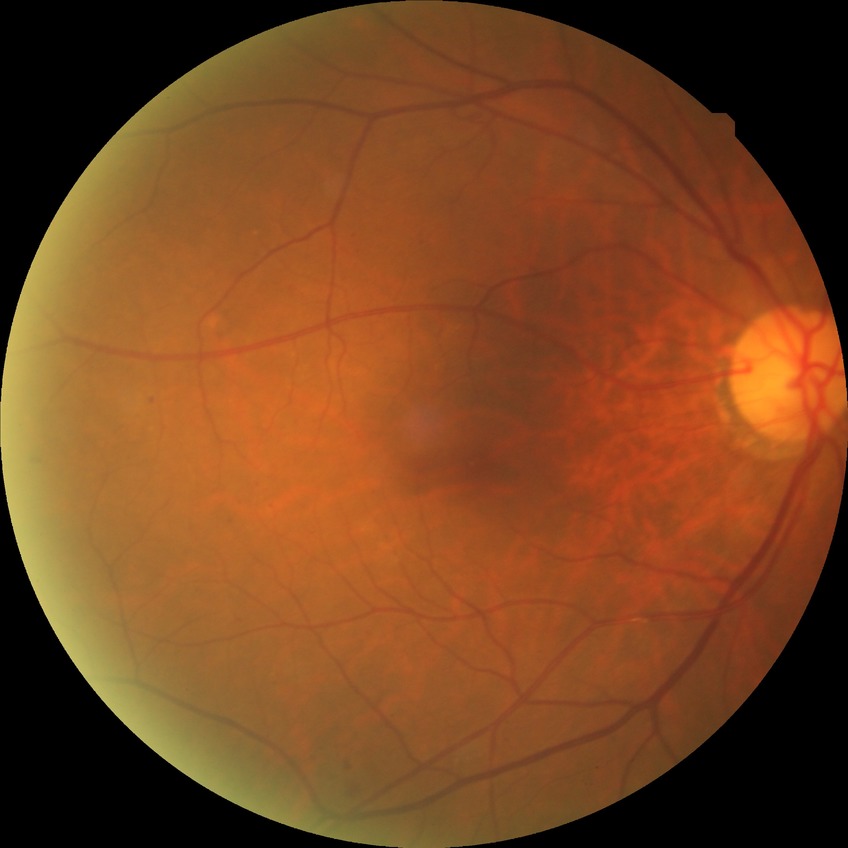

Modified Davis grade: SDR.